Image size 2352x1568: 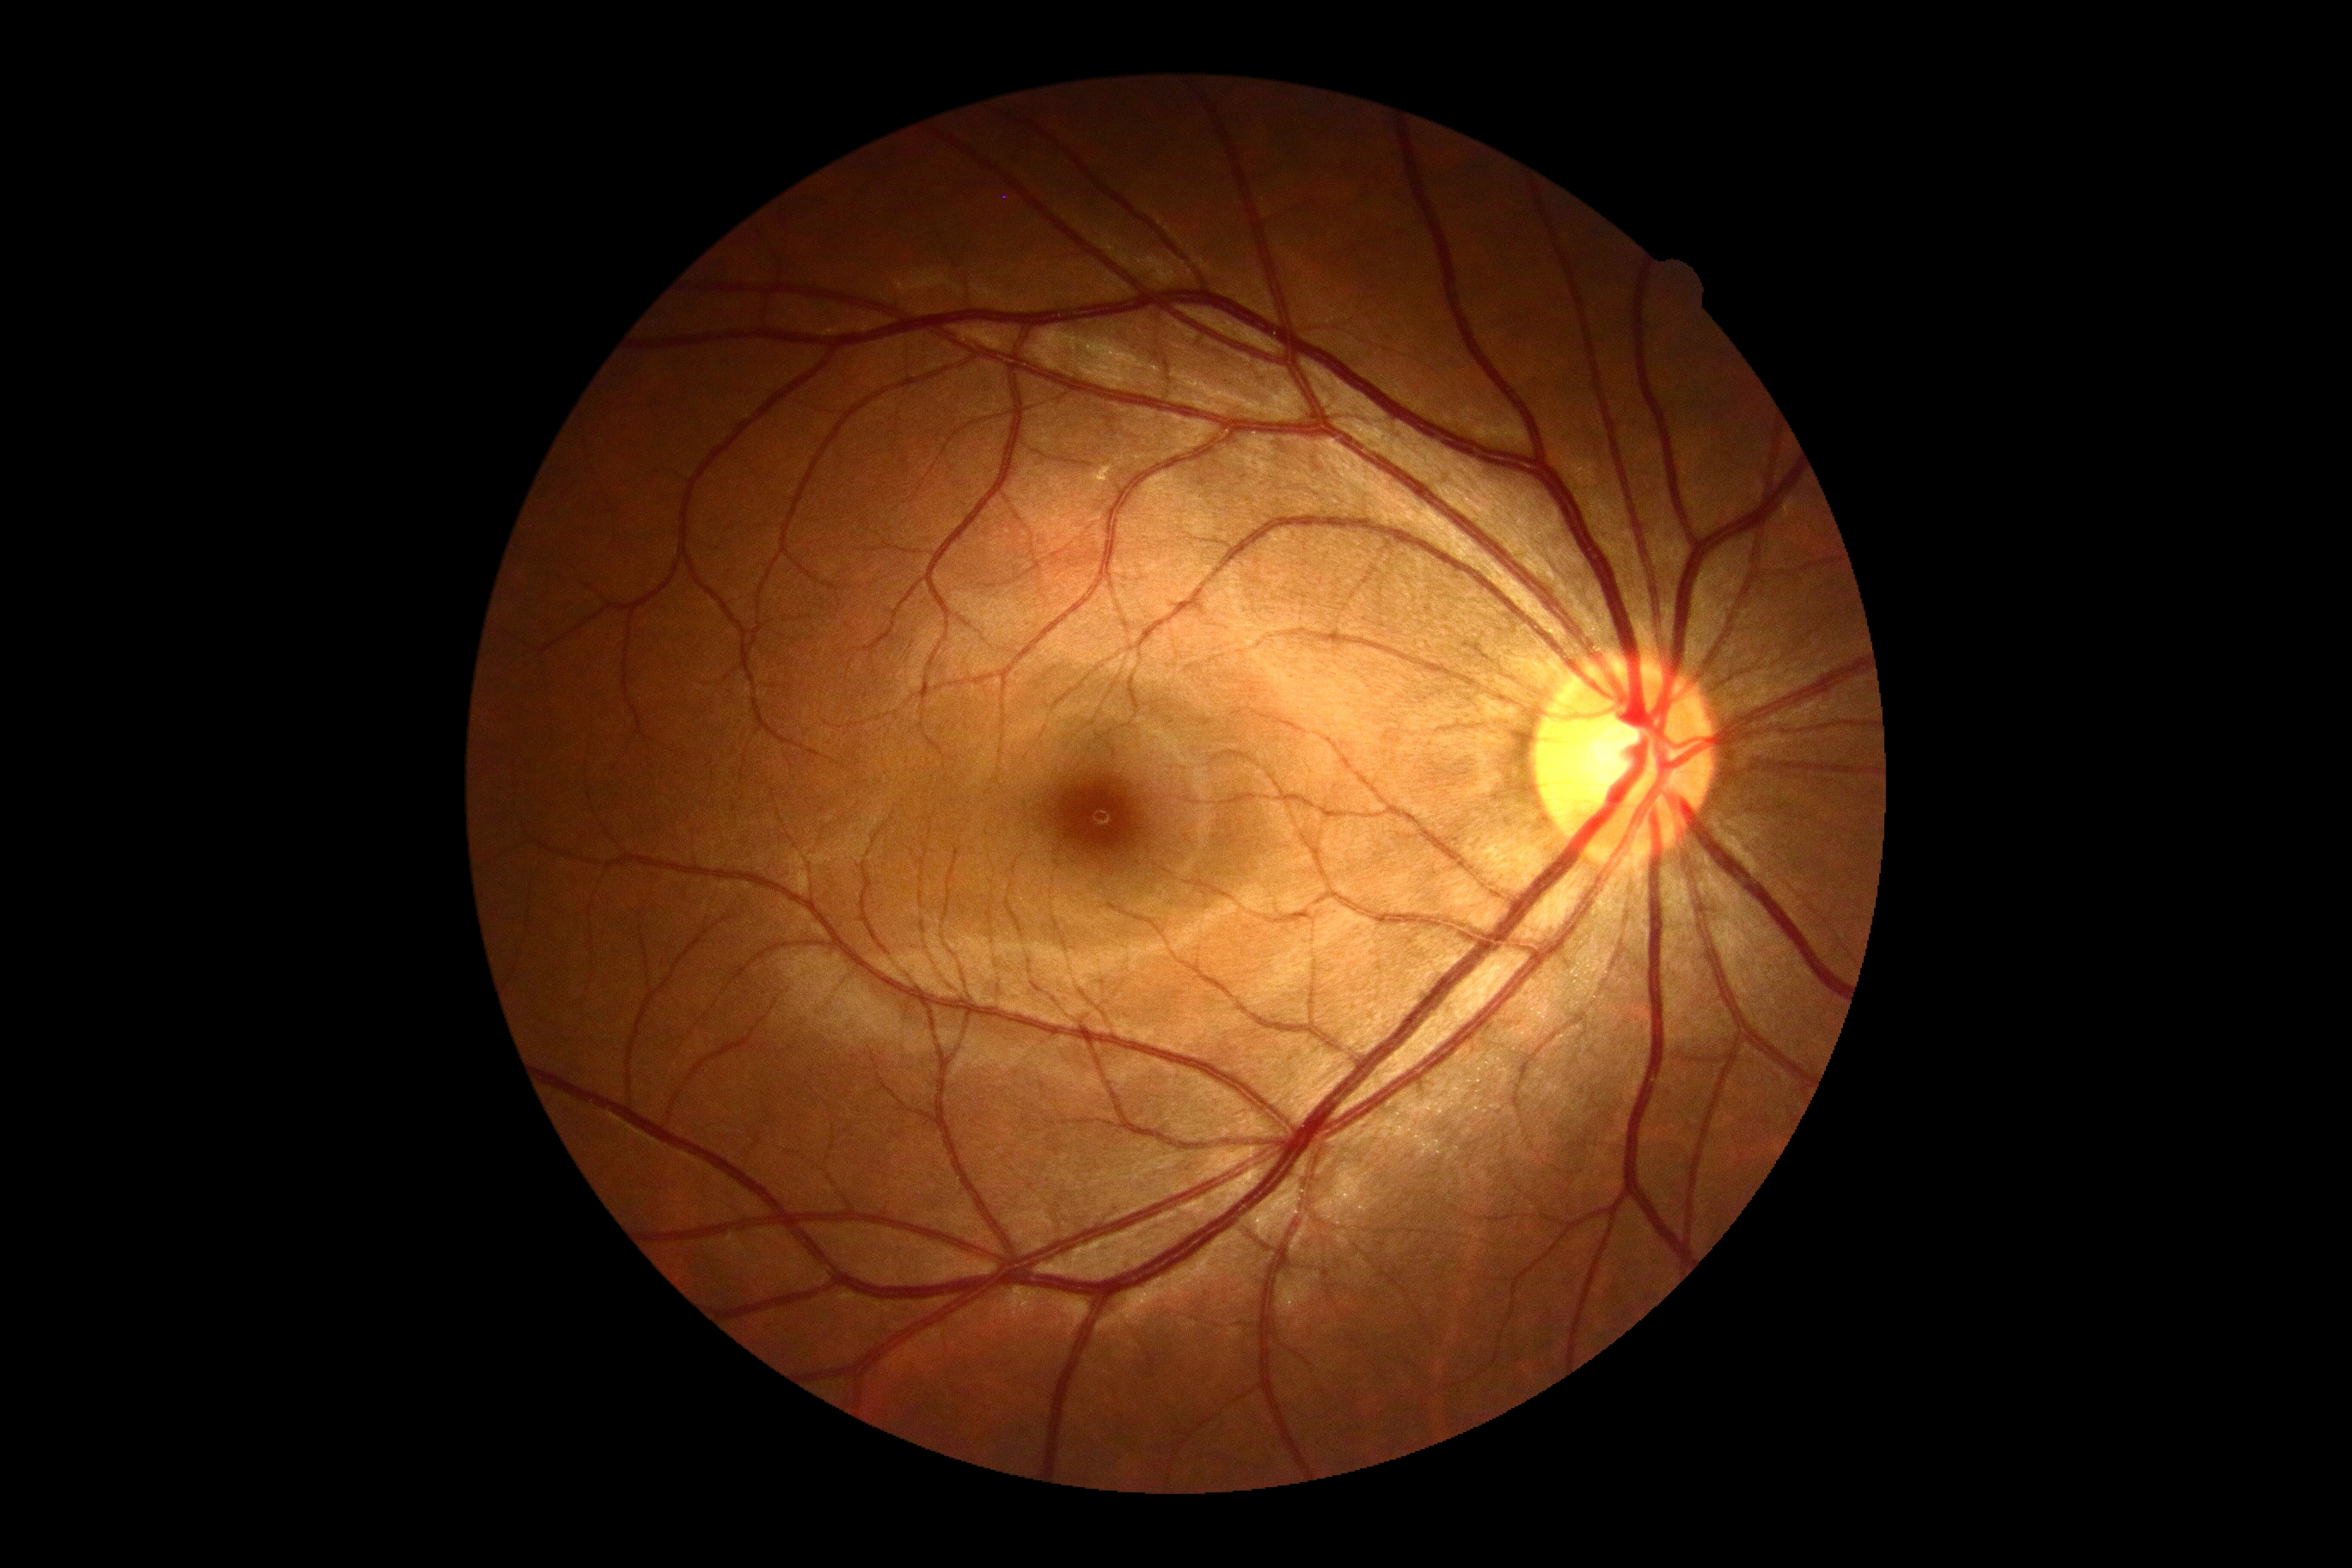 Diabetic retinopathy grade is 0.